Camera: NIDEK AFC-230. Diabetic retinopathy graded by the modified Davis classification:
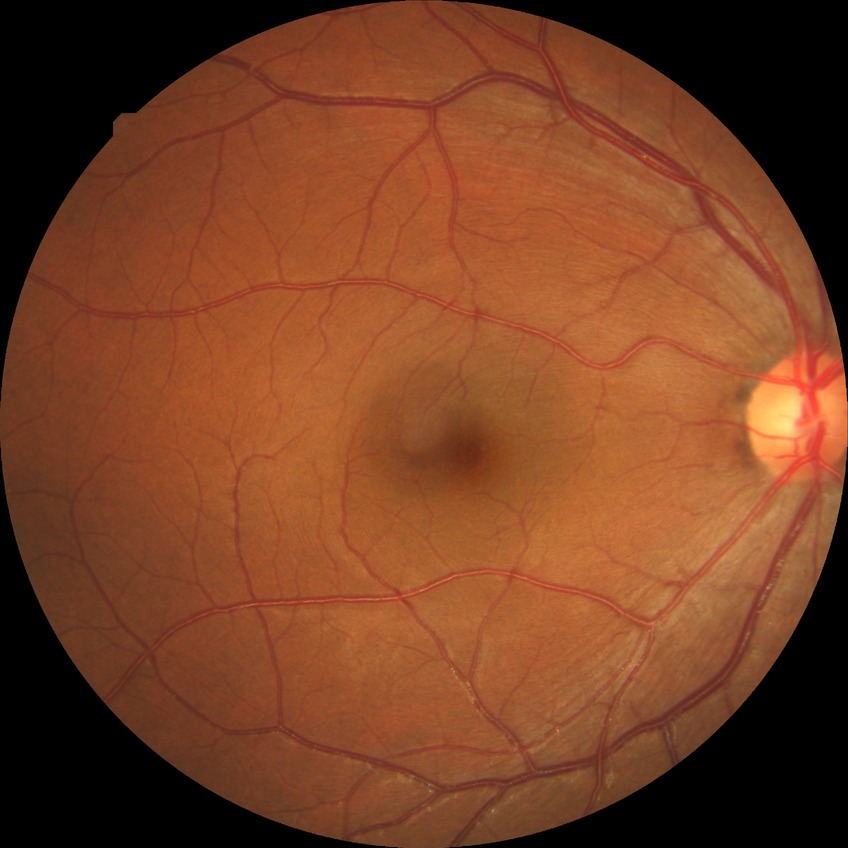
davis_grade: NDR (no diabetic retinopathy)